FOV: 200 degrees, image size 1924x1556, ultra-widefield (UWF) fundus image
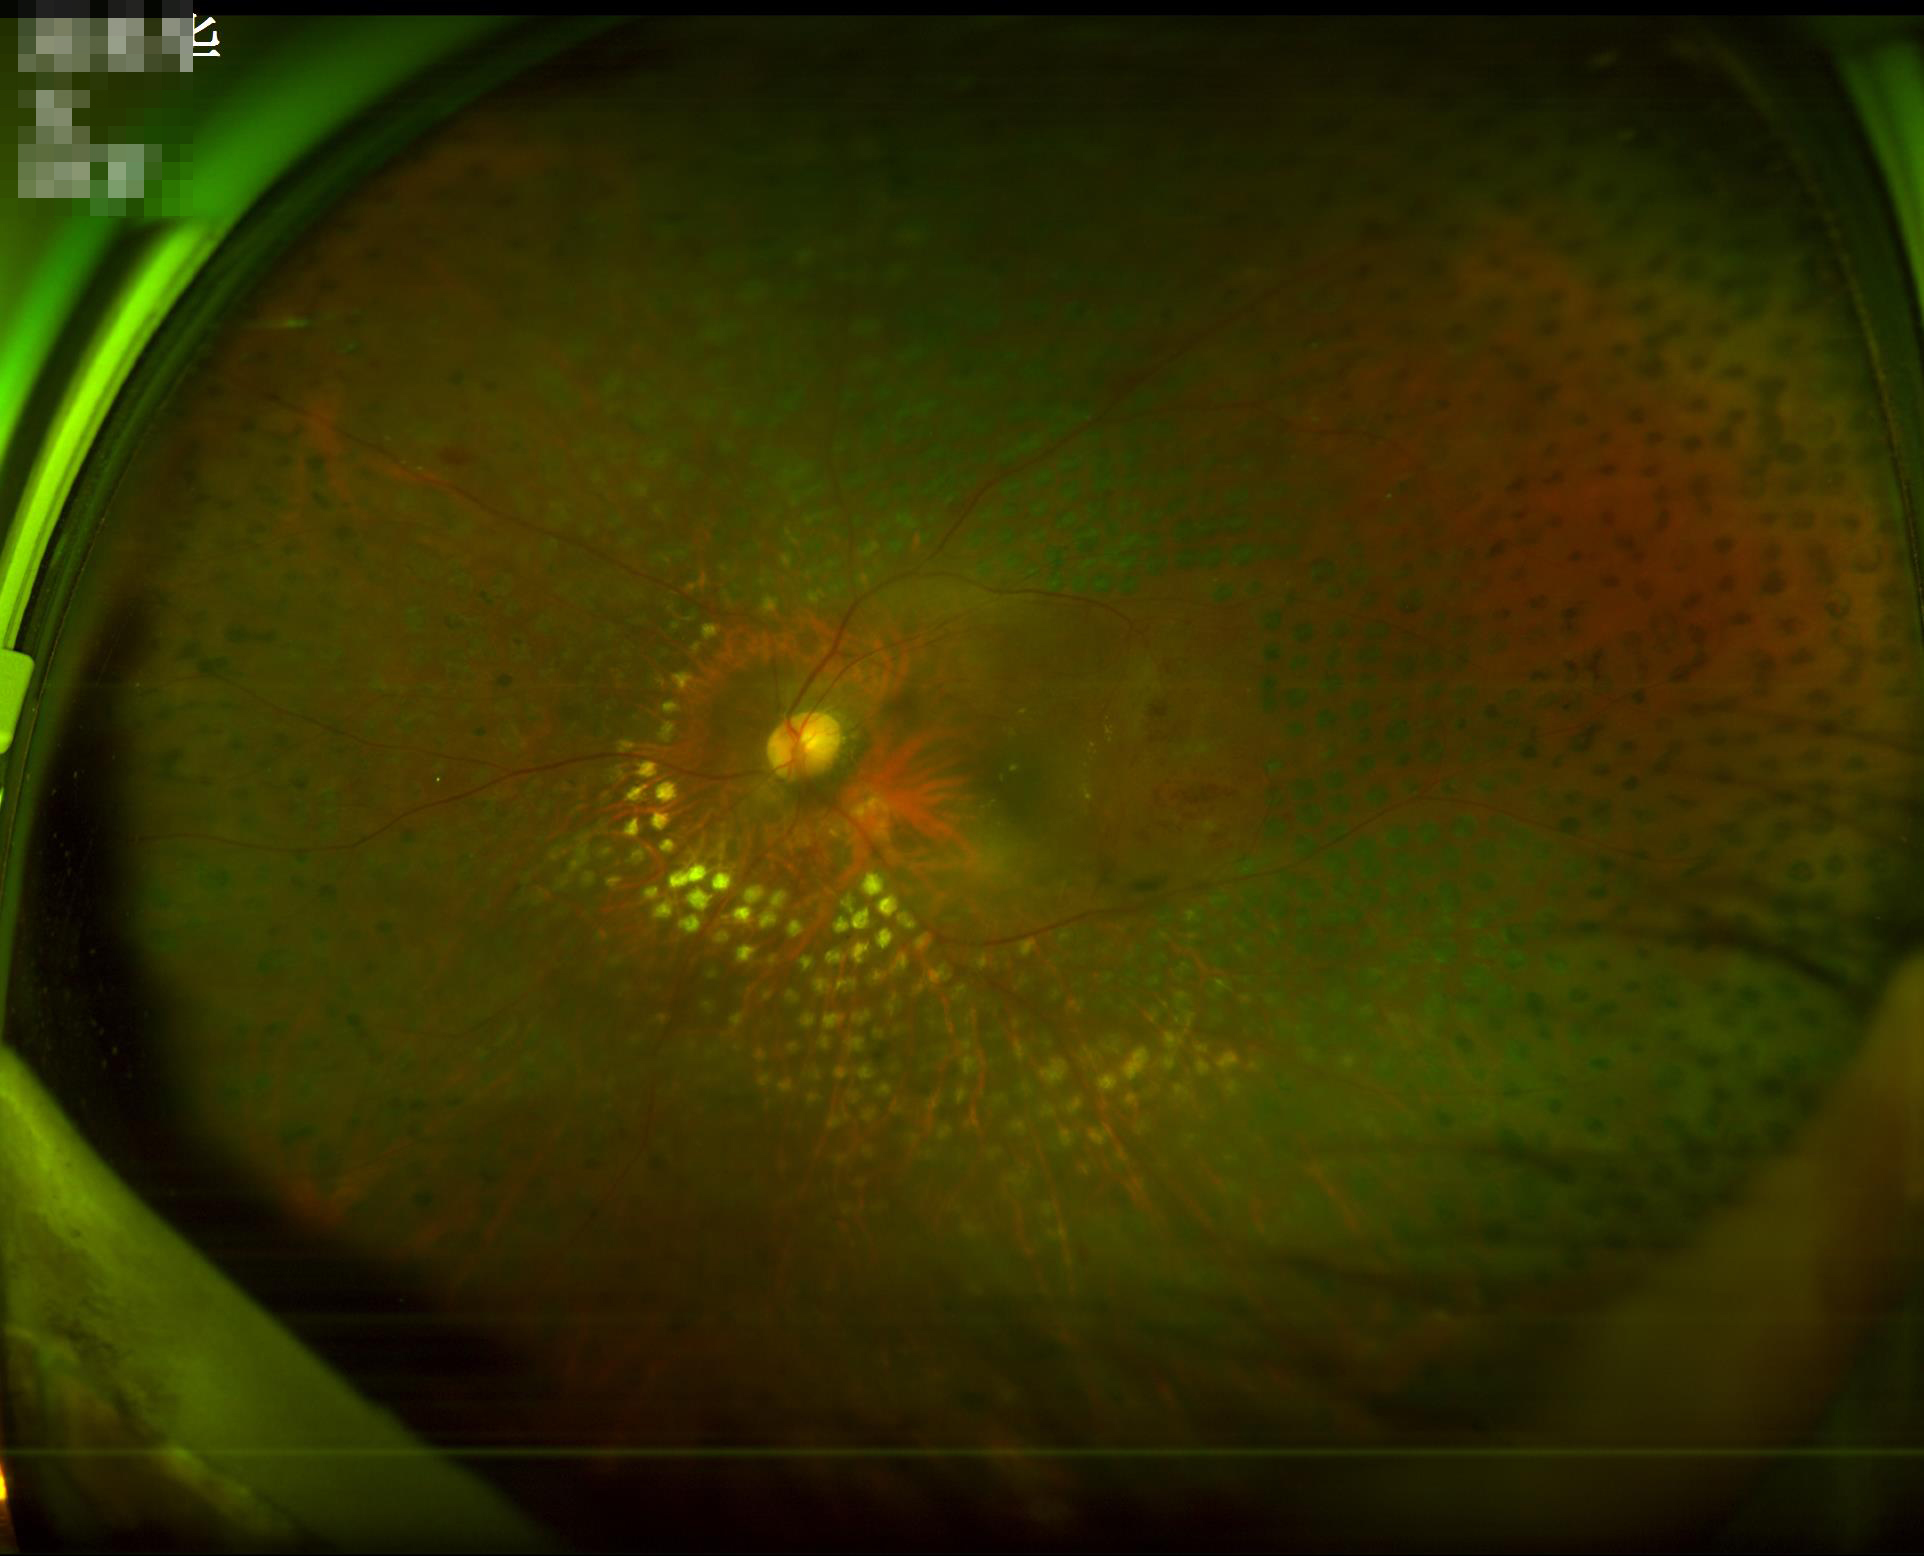
Overall image quality: good, gradable; Focus: optic disc, vessels, and background in focus; Illumination: even and well-balanced; Contrast: low, vessels and details hard to distinguish.